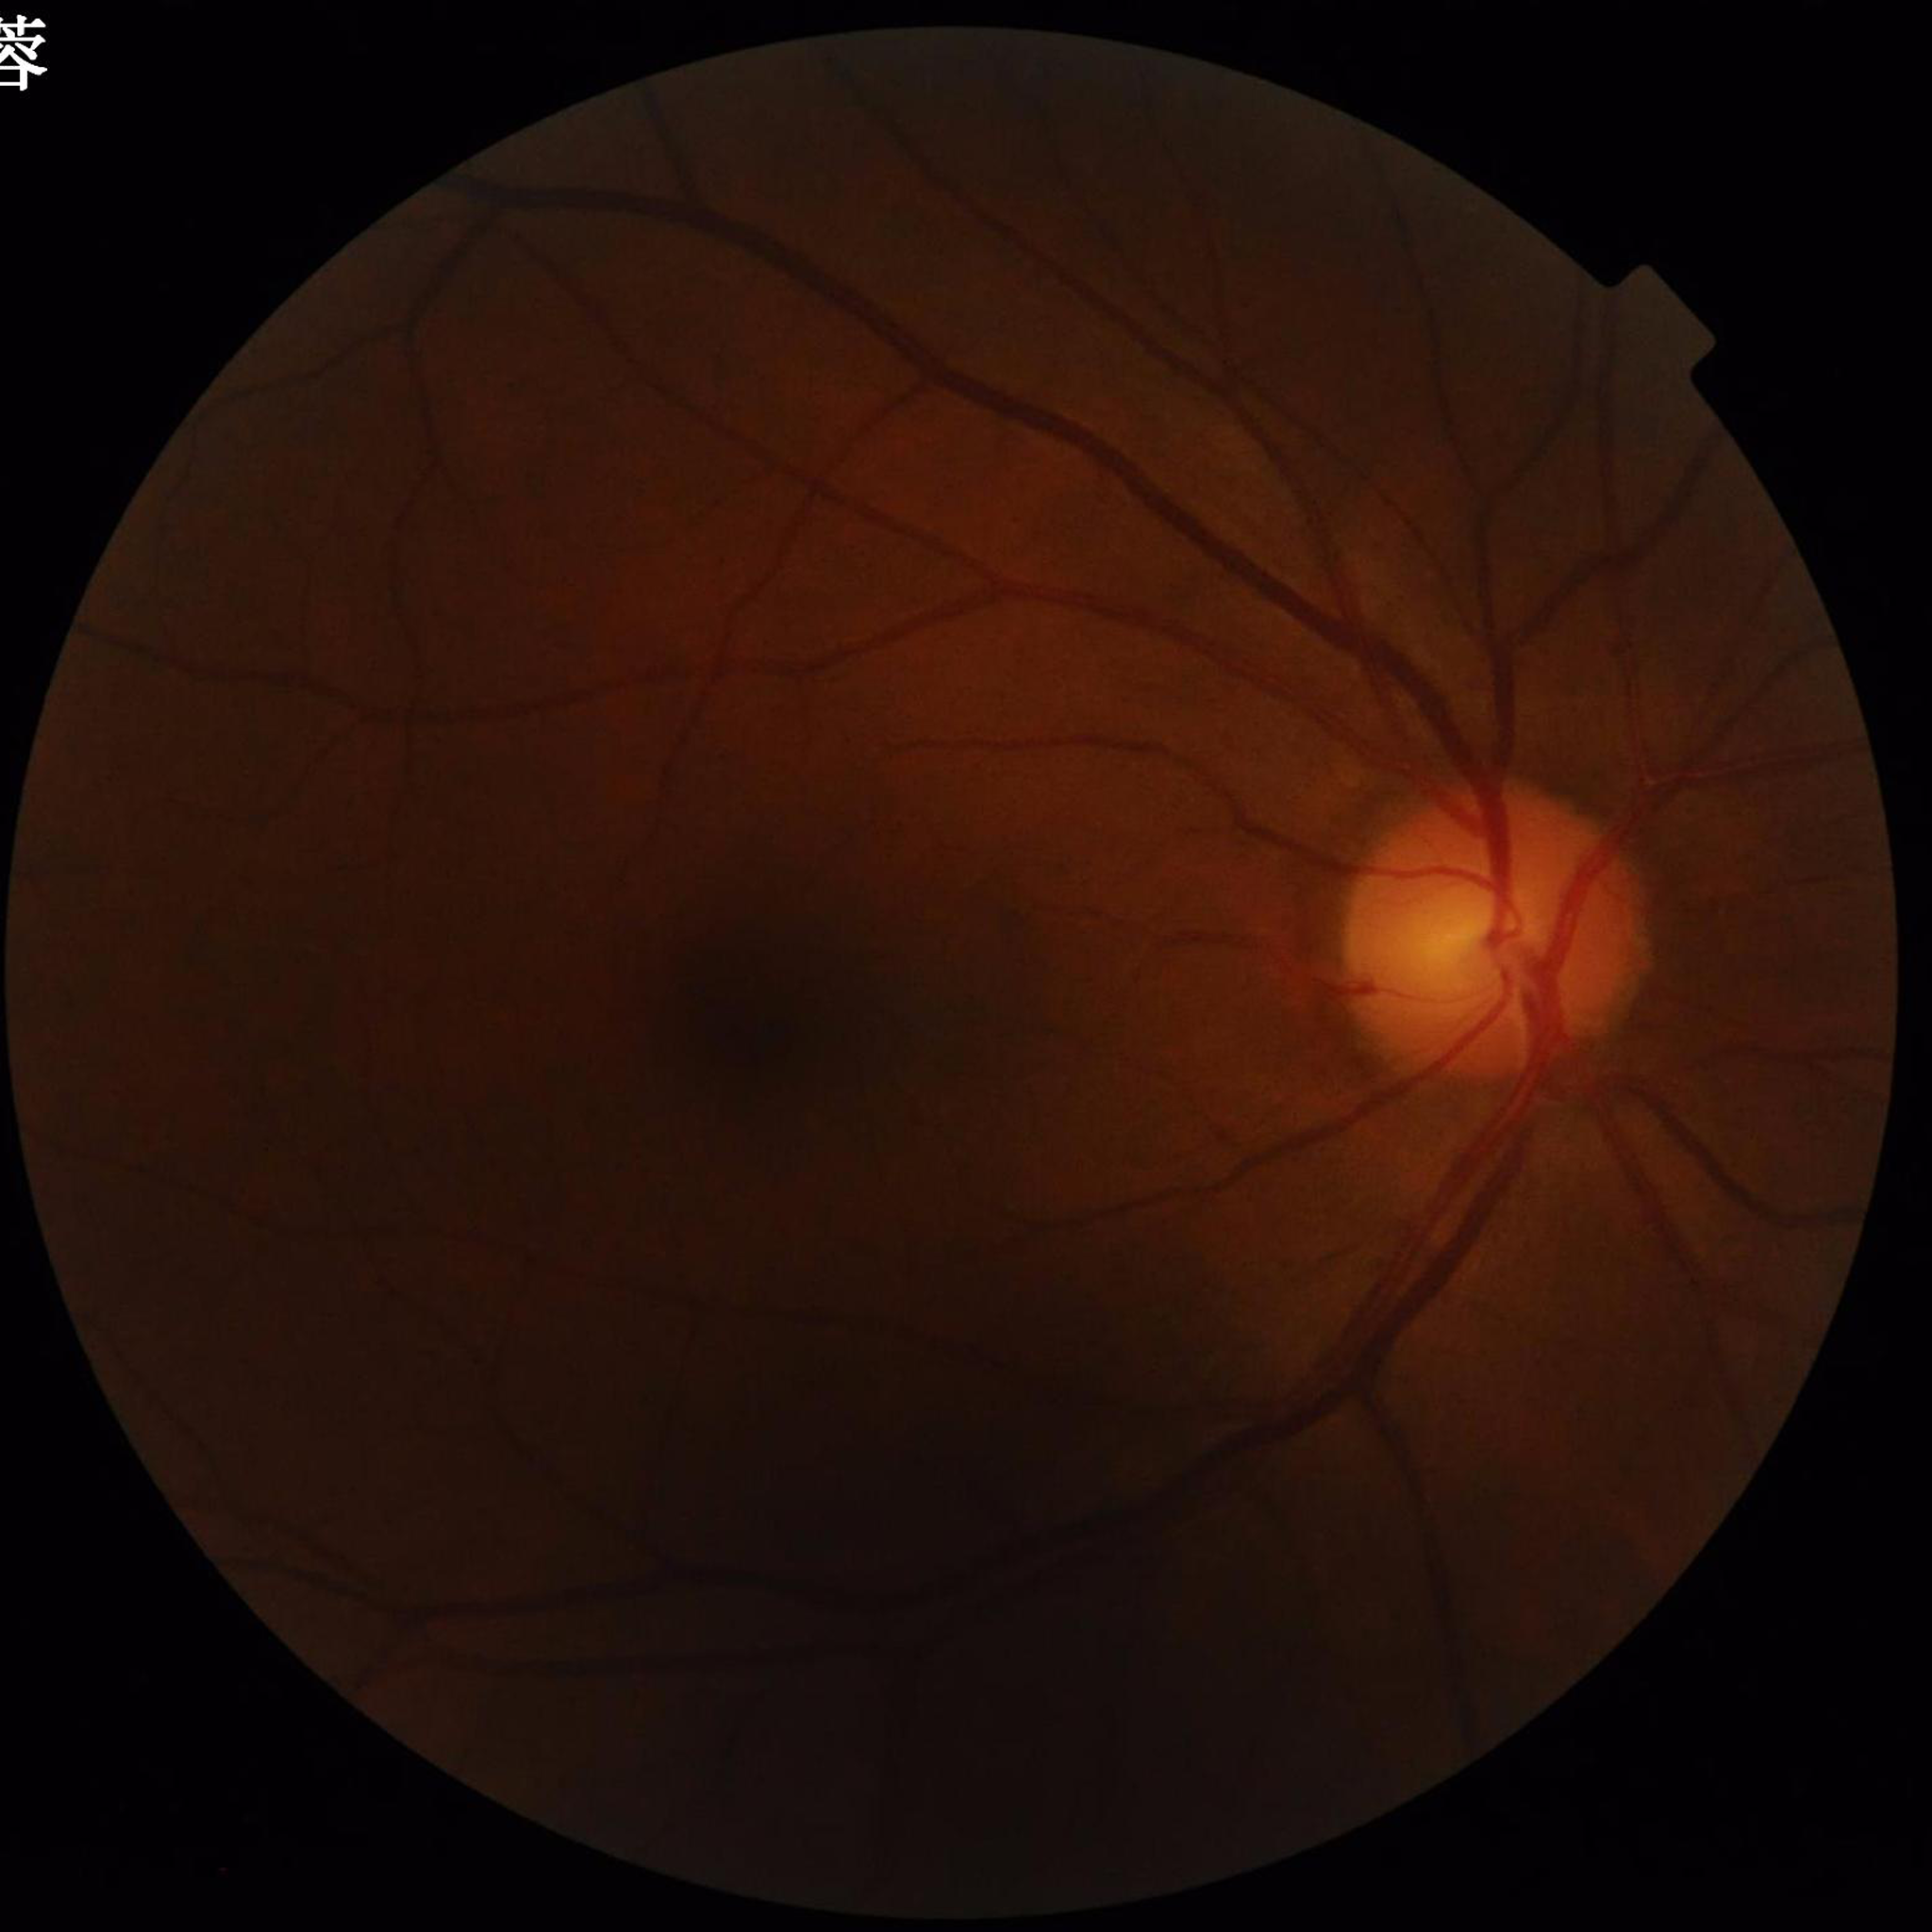

{
  "diagnosis": "glaucoma"
}